2212x1659px; 45° field of view; CFP
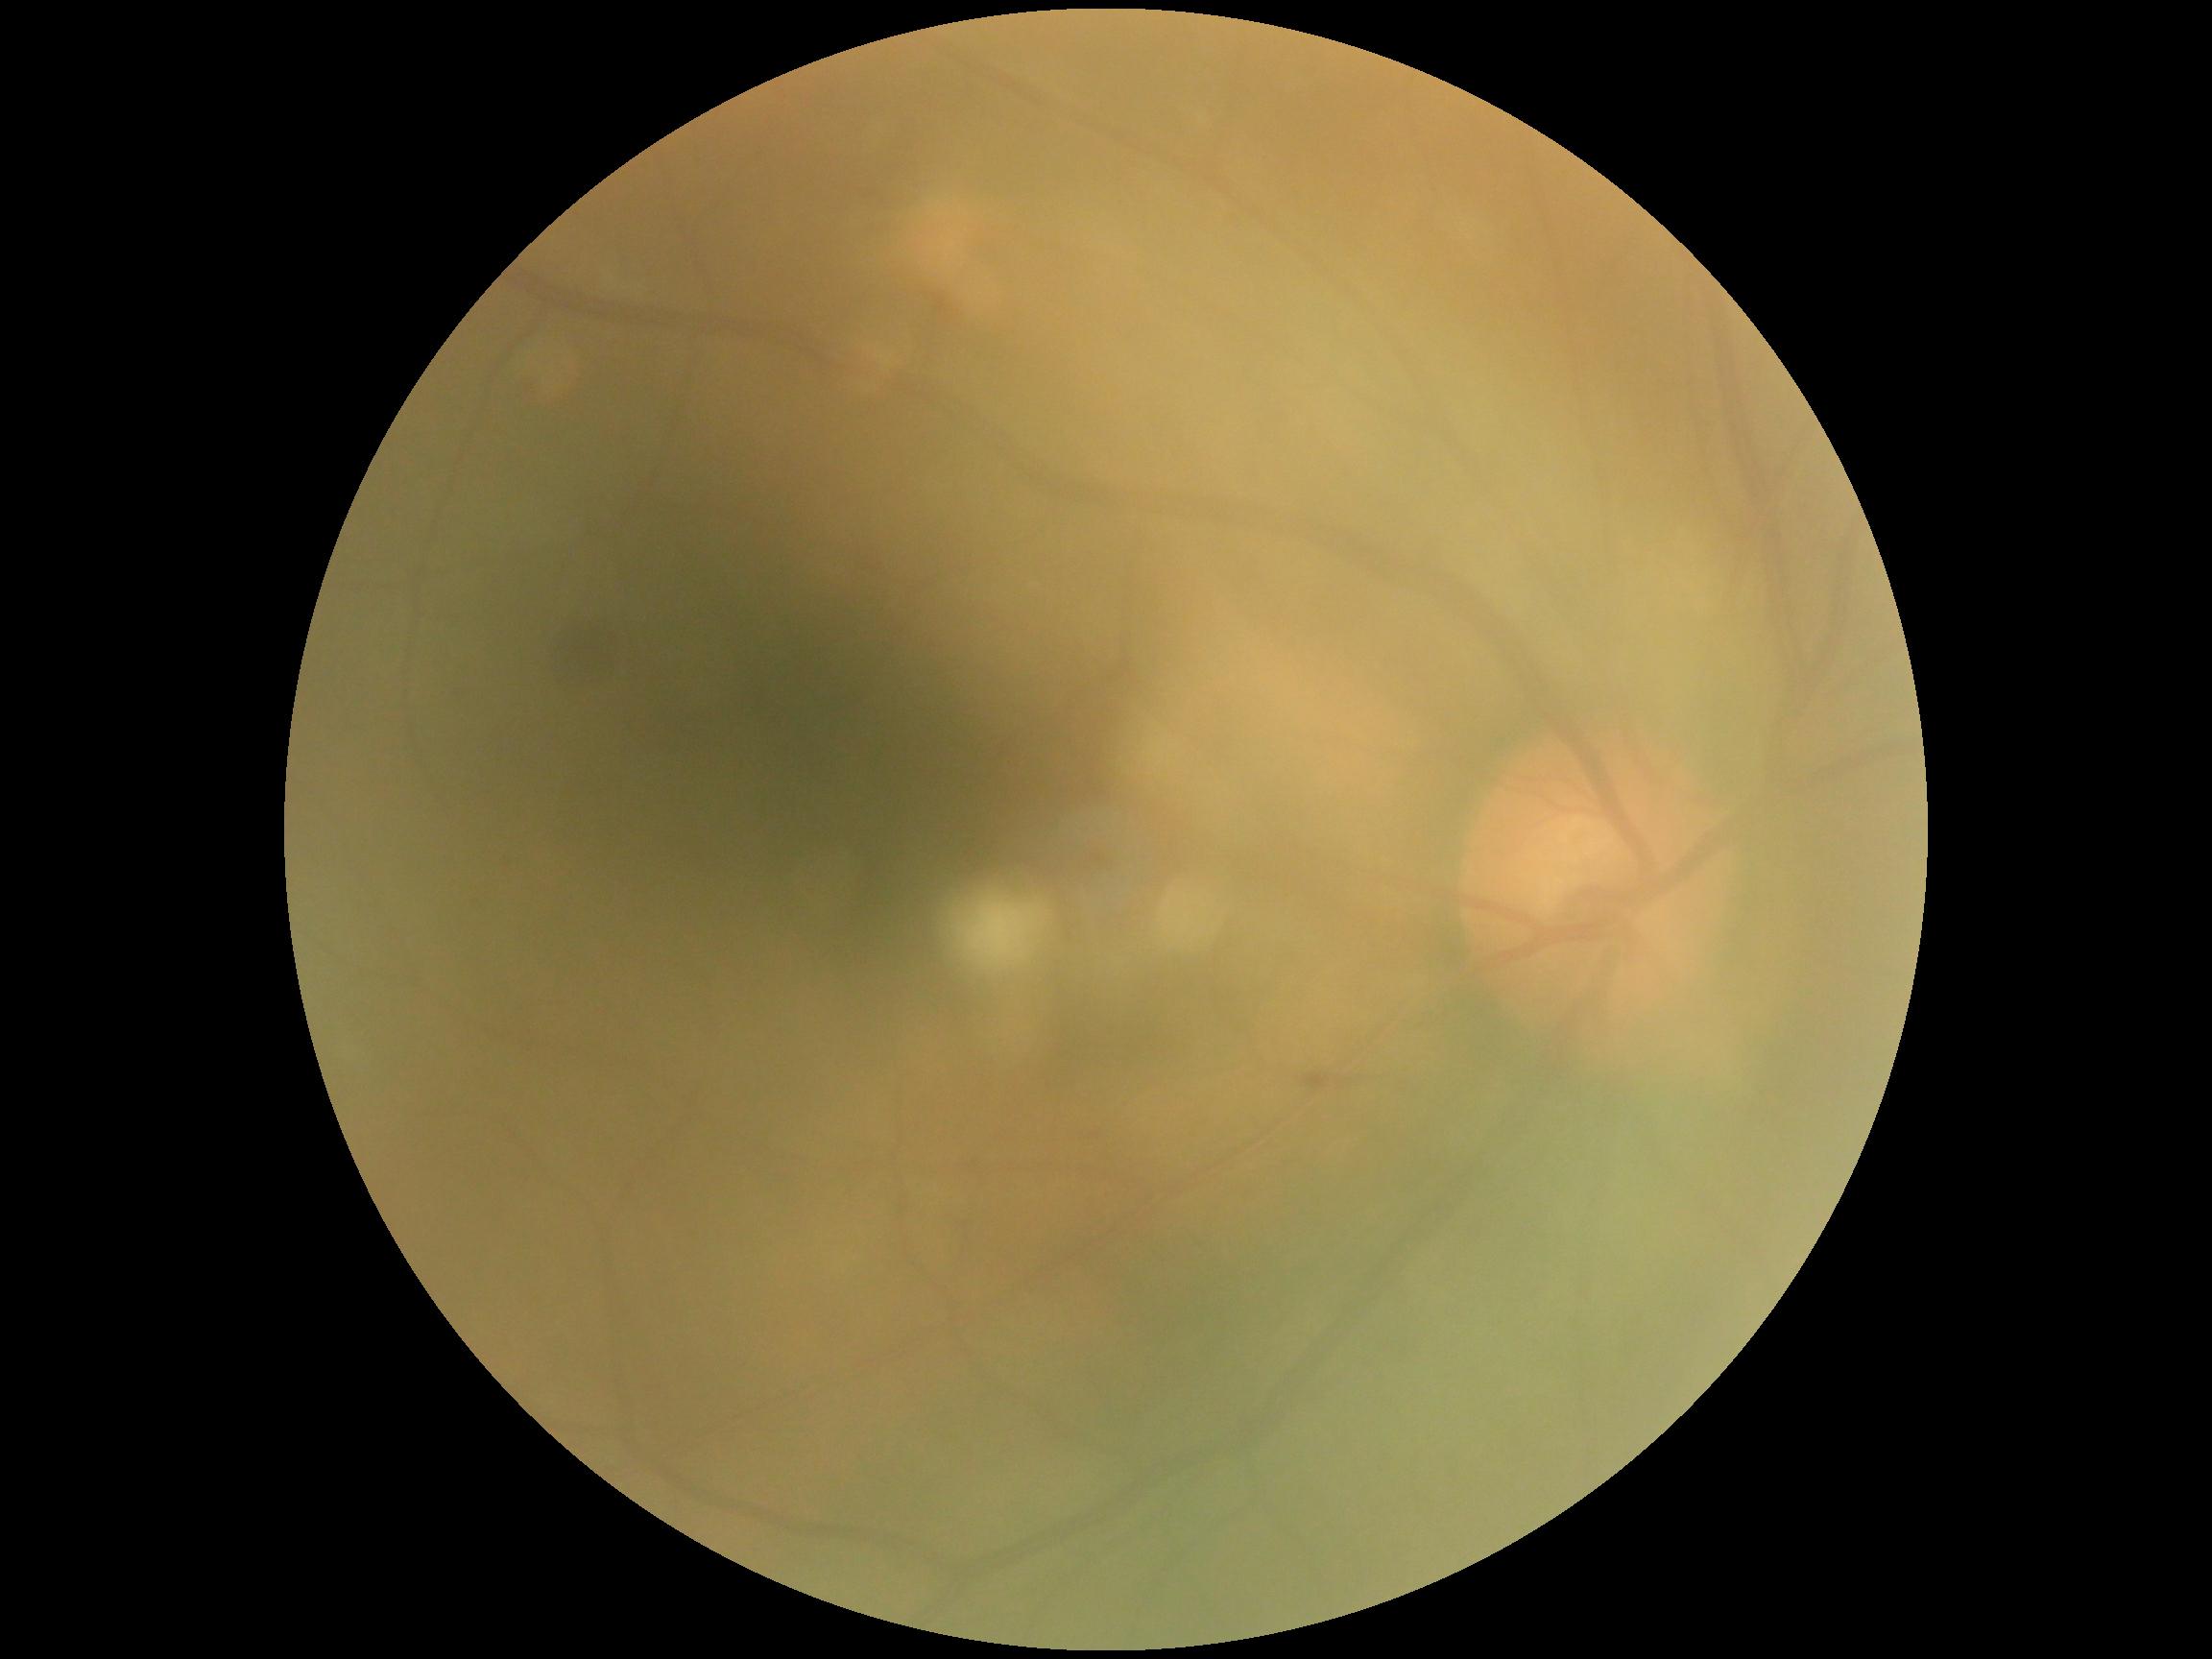
diabetic retinopathy (DR) = moderate NPDR (grade 2)